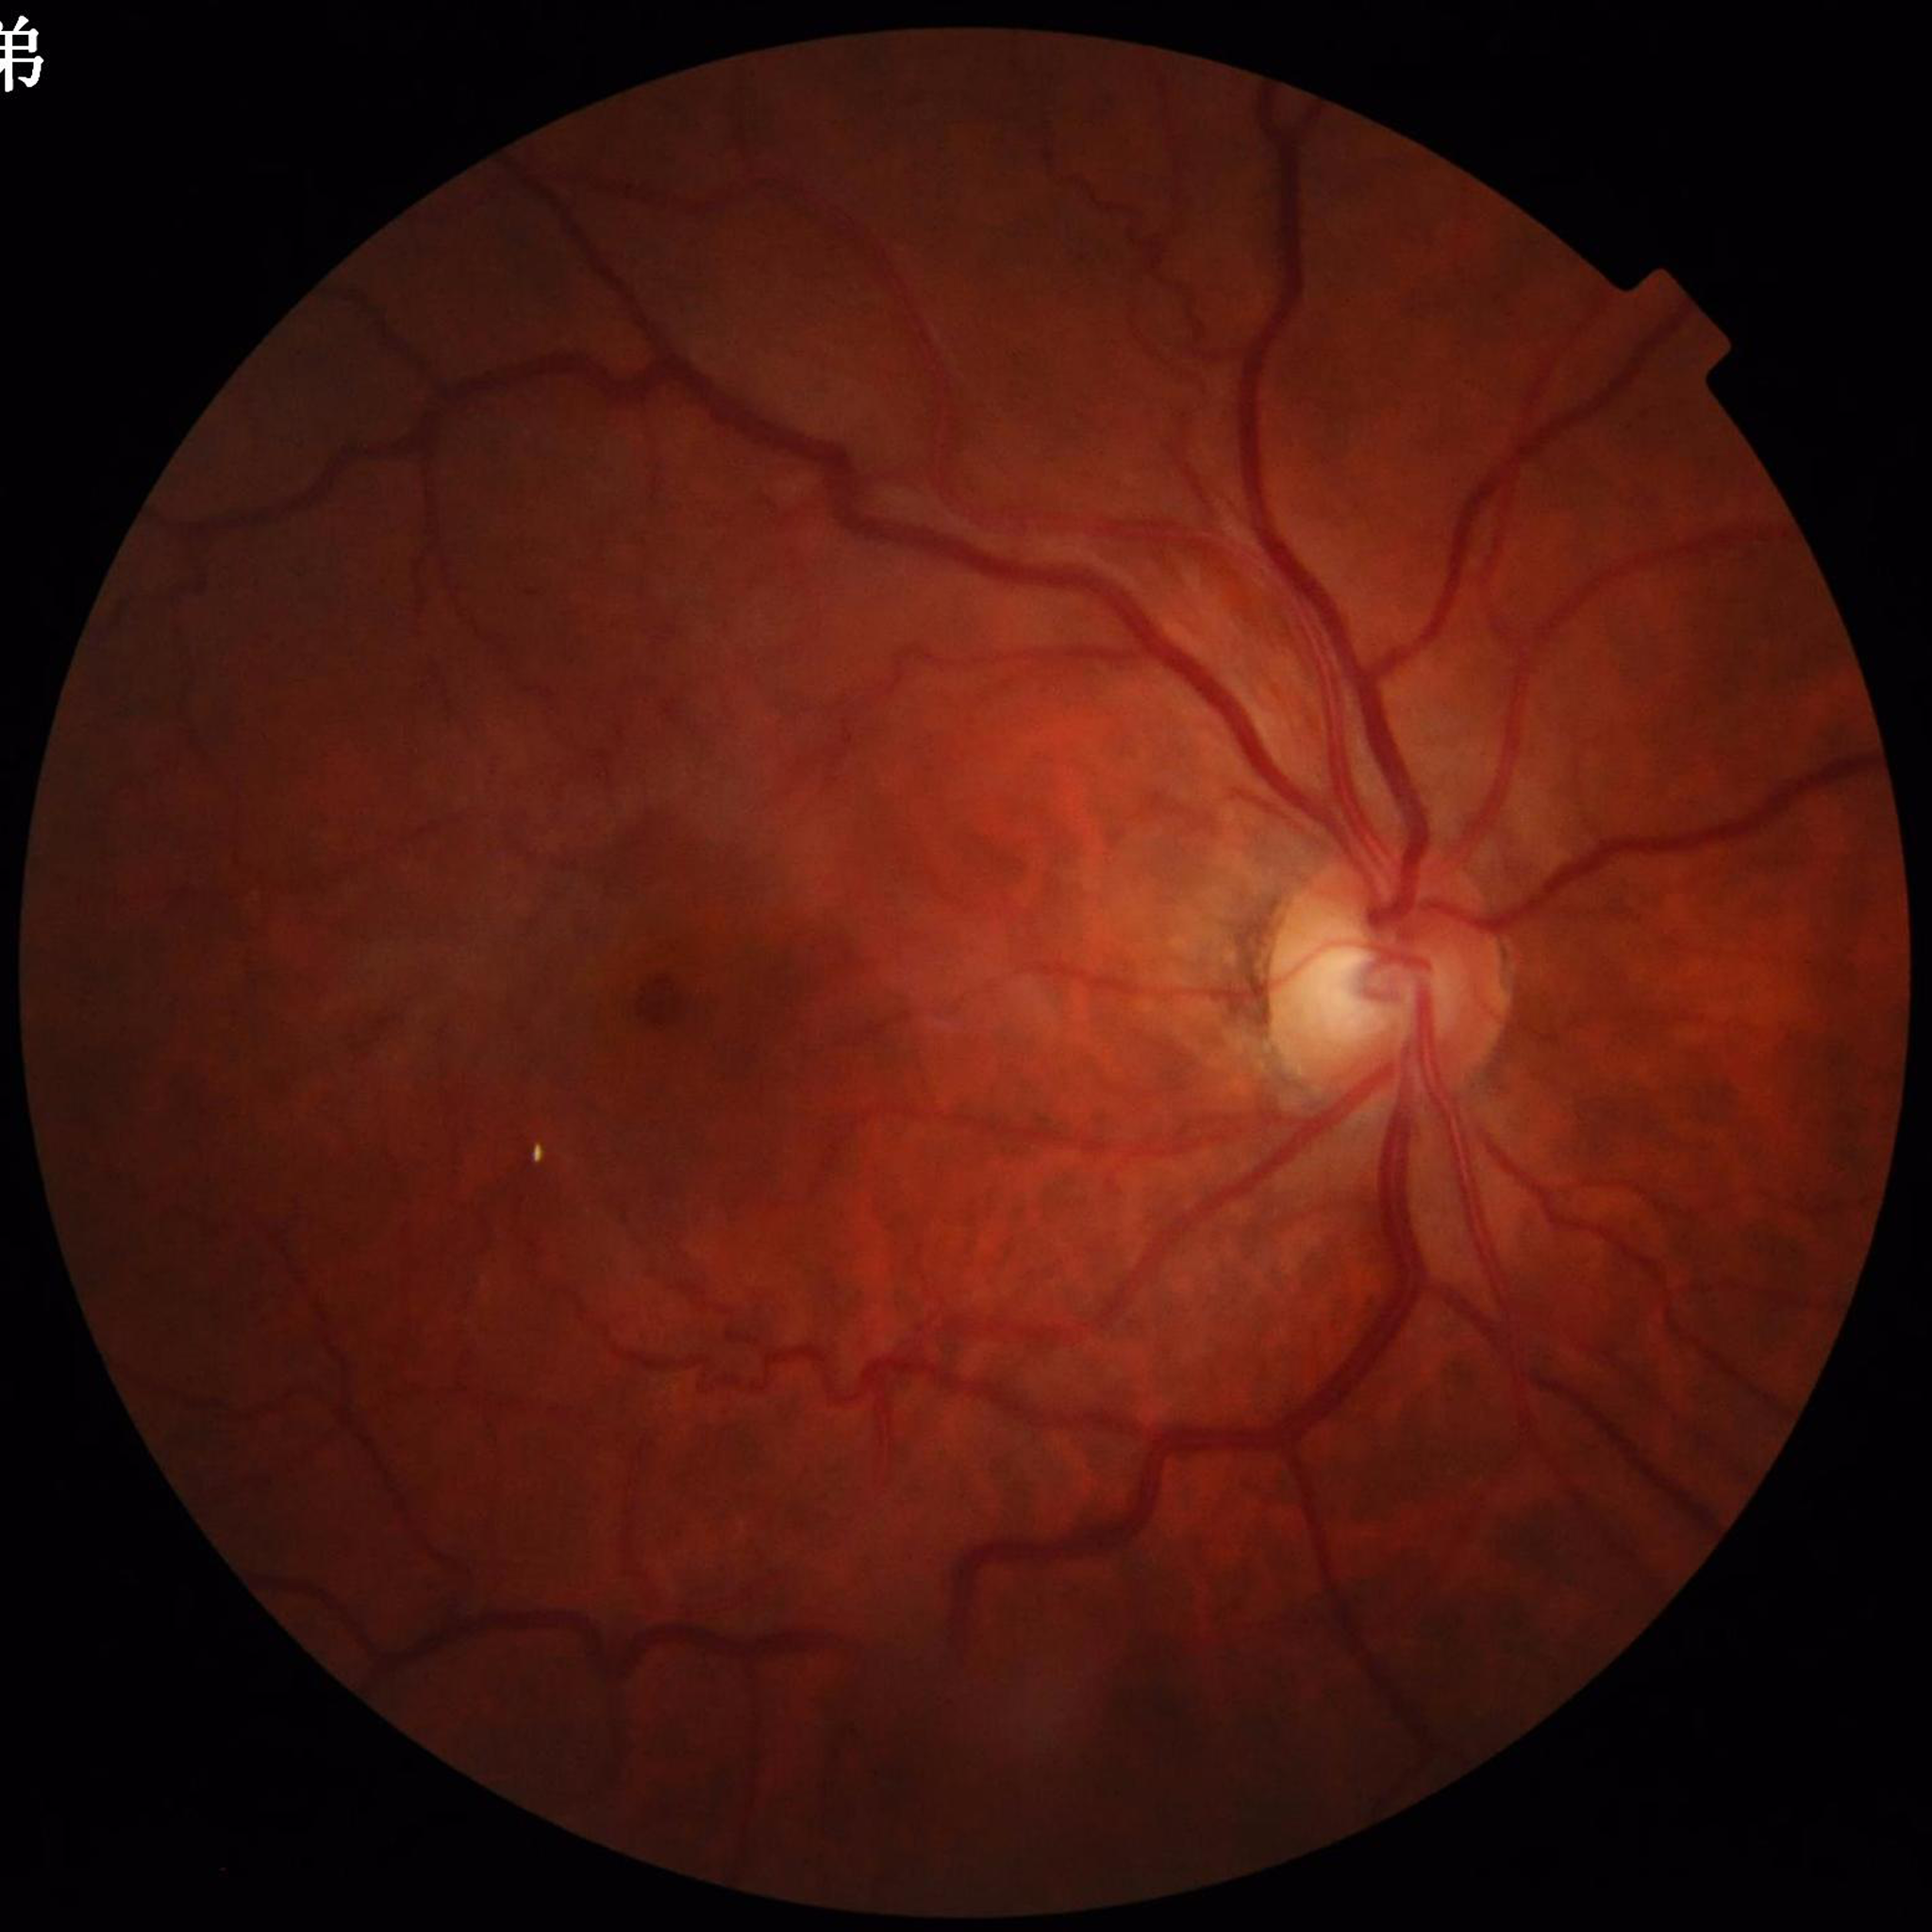

Image quality: satisfactory
Disease class: diabetic retinopathy